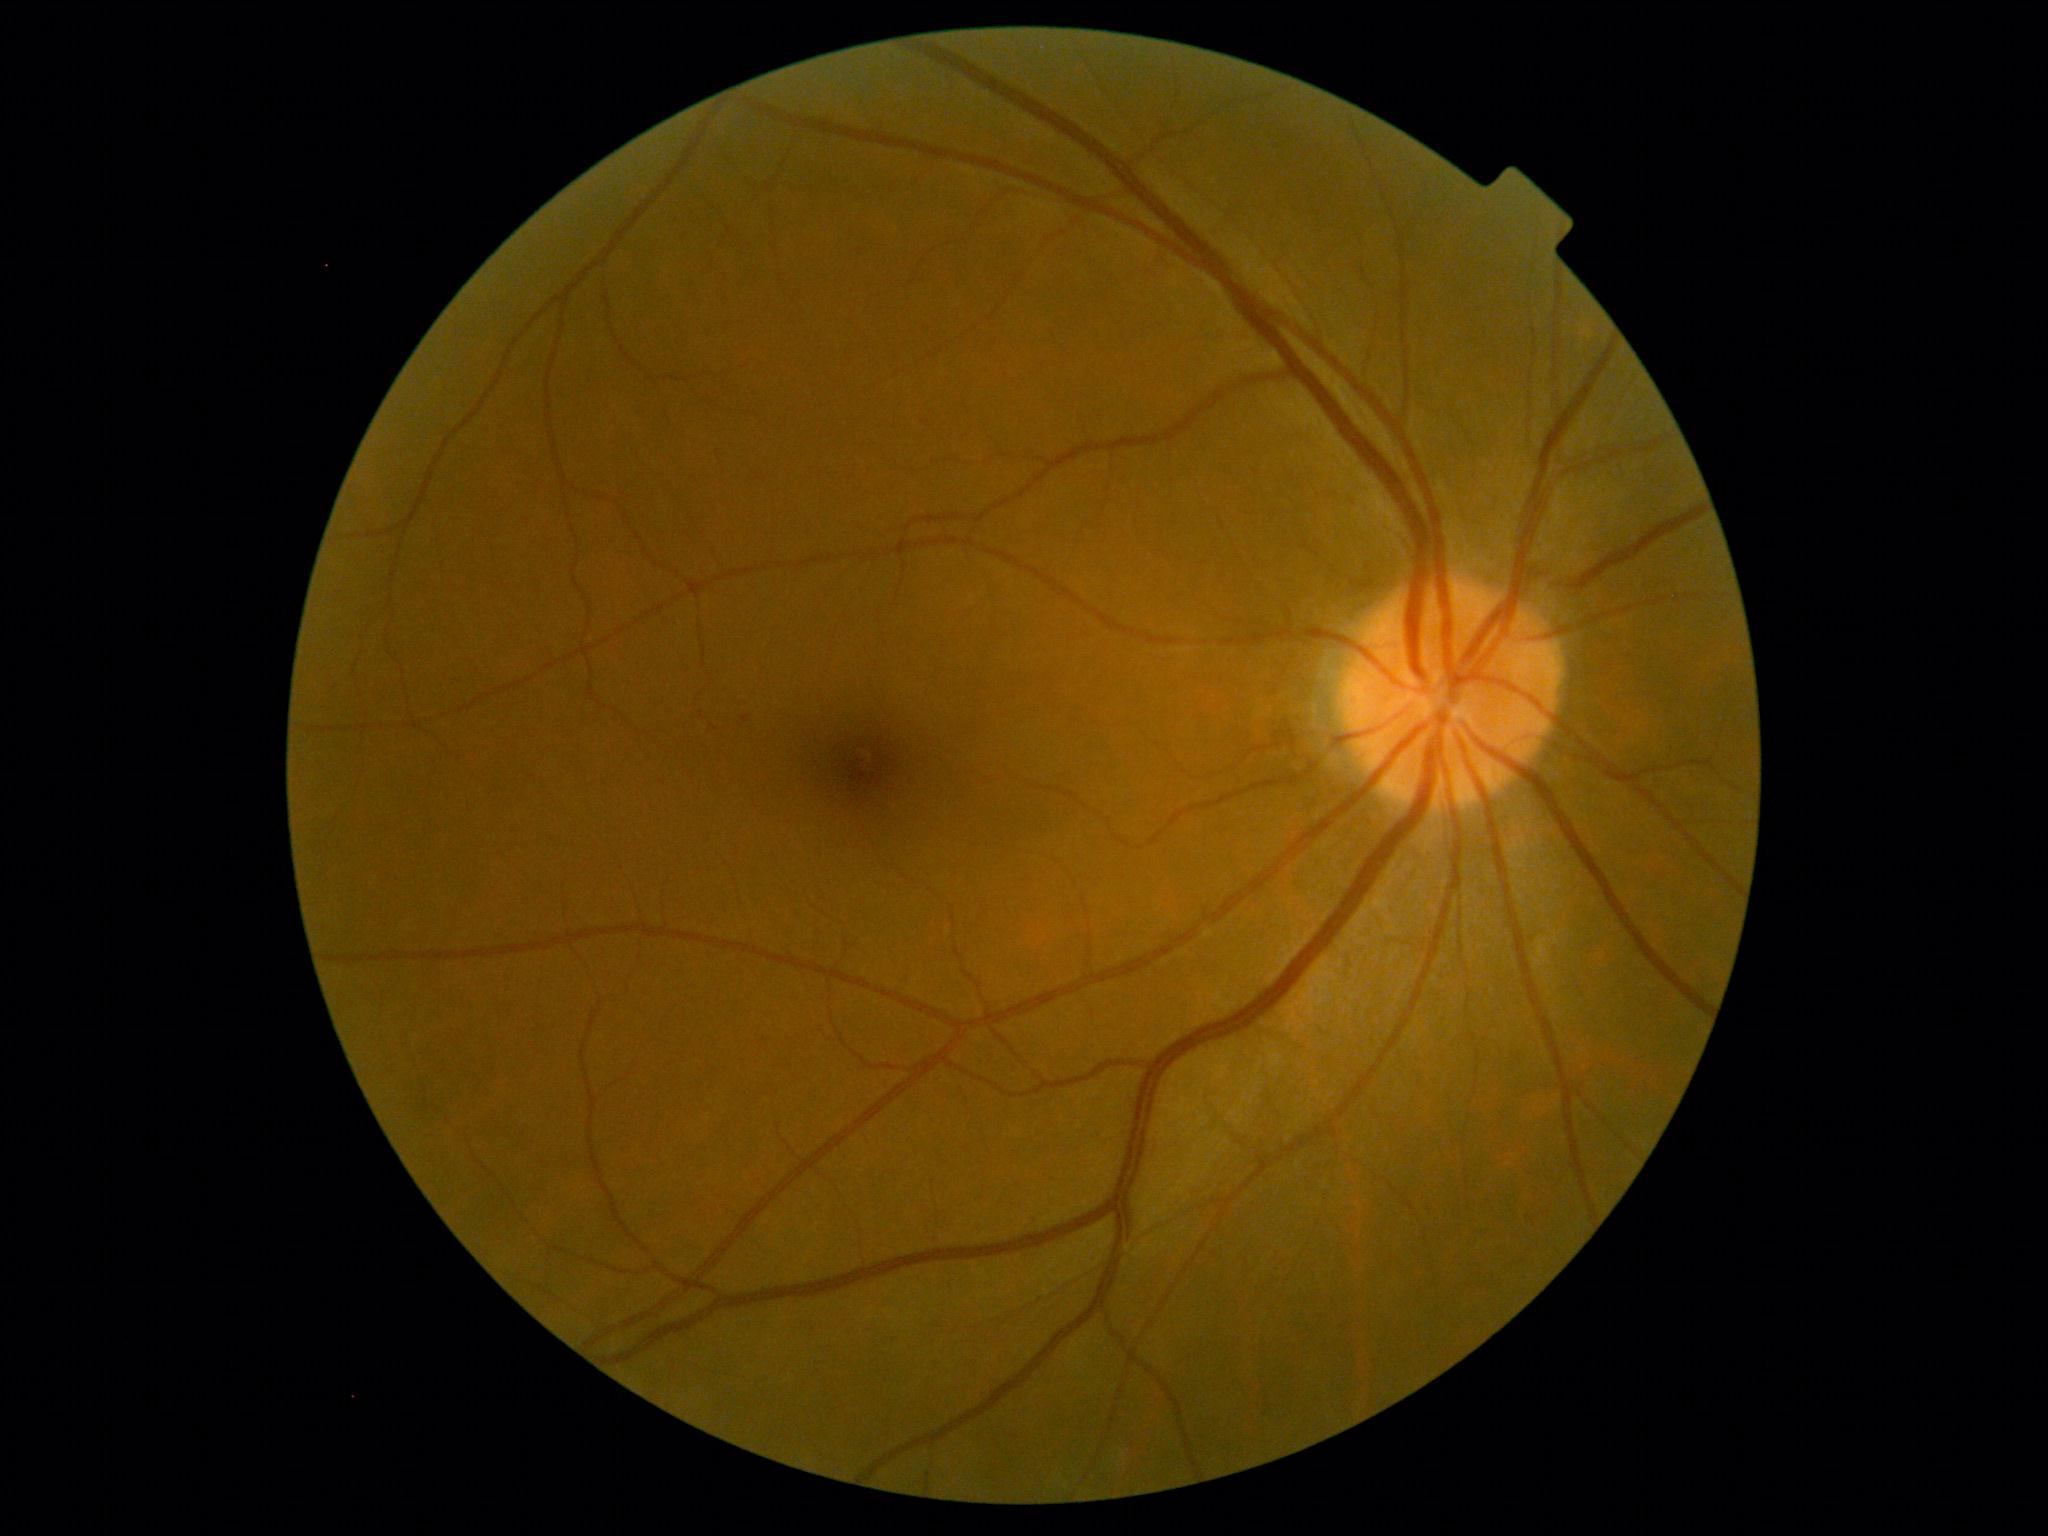
dr_grade: mild non-proliferative diabetic retinopathy (grade 1) — presence of microaneurysms only